Modified Davis grading. 45° FOV.
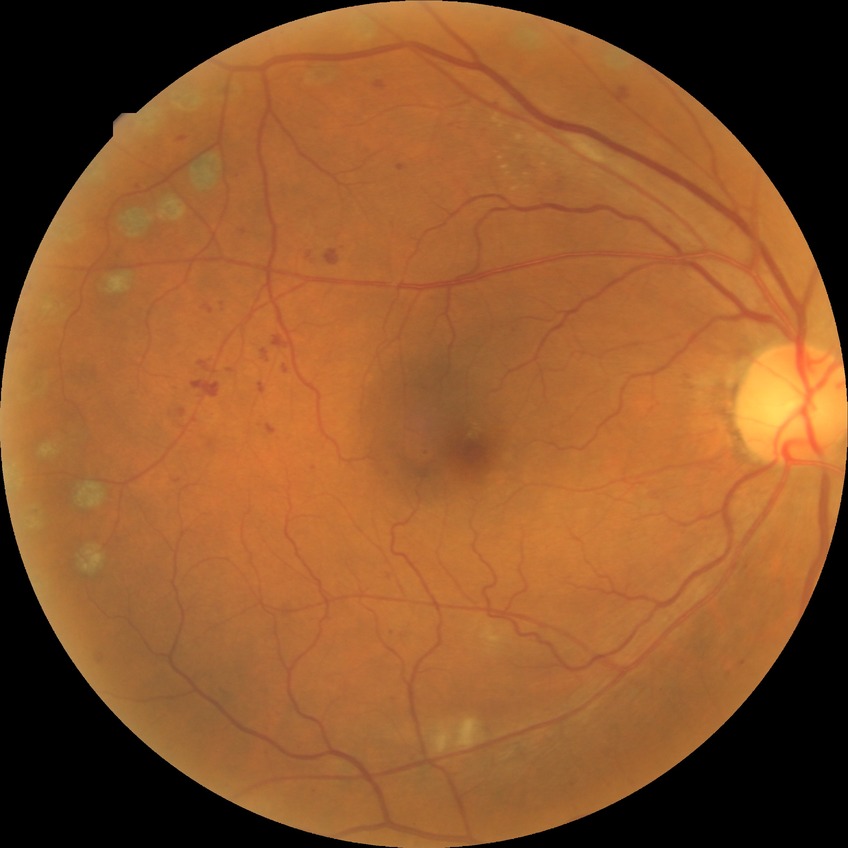

Retinopathy stage: proliferative diabetic retinopathy.